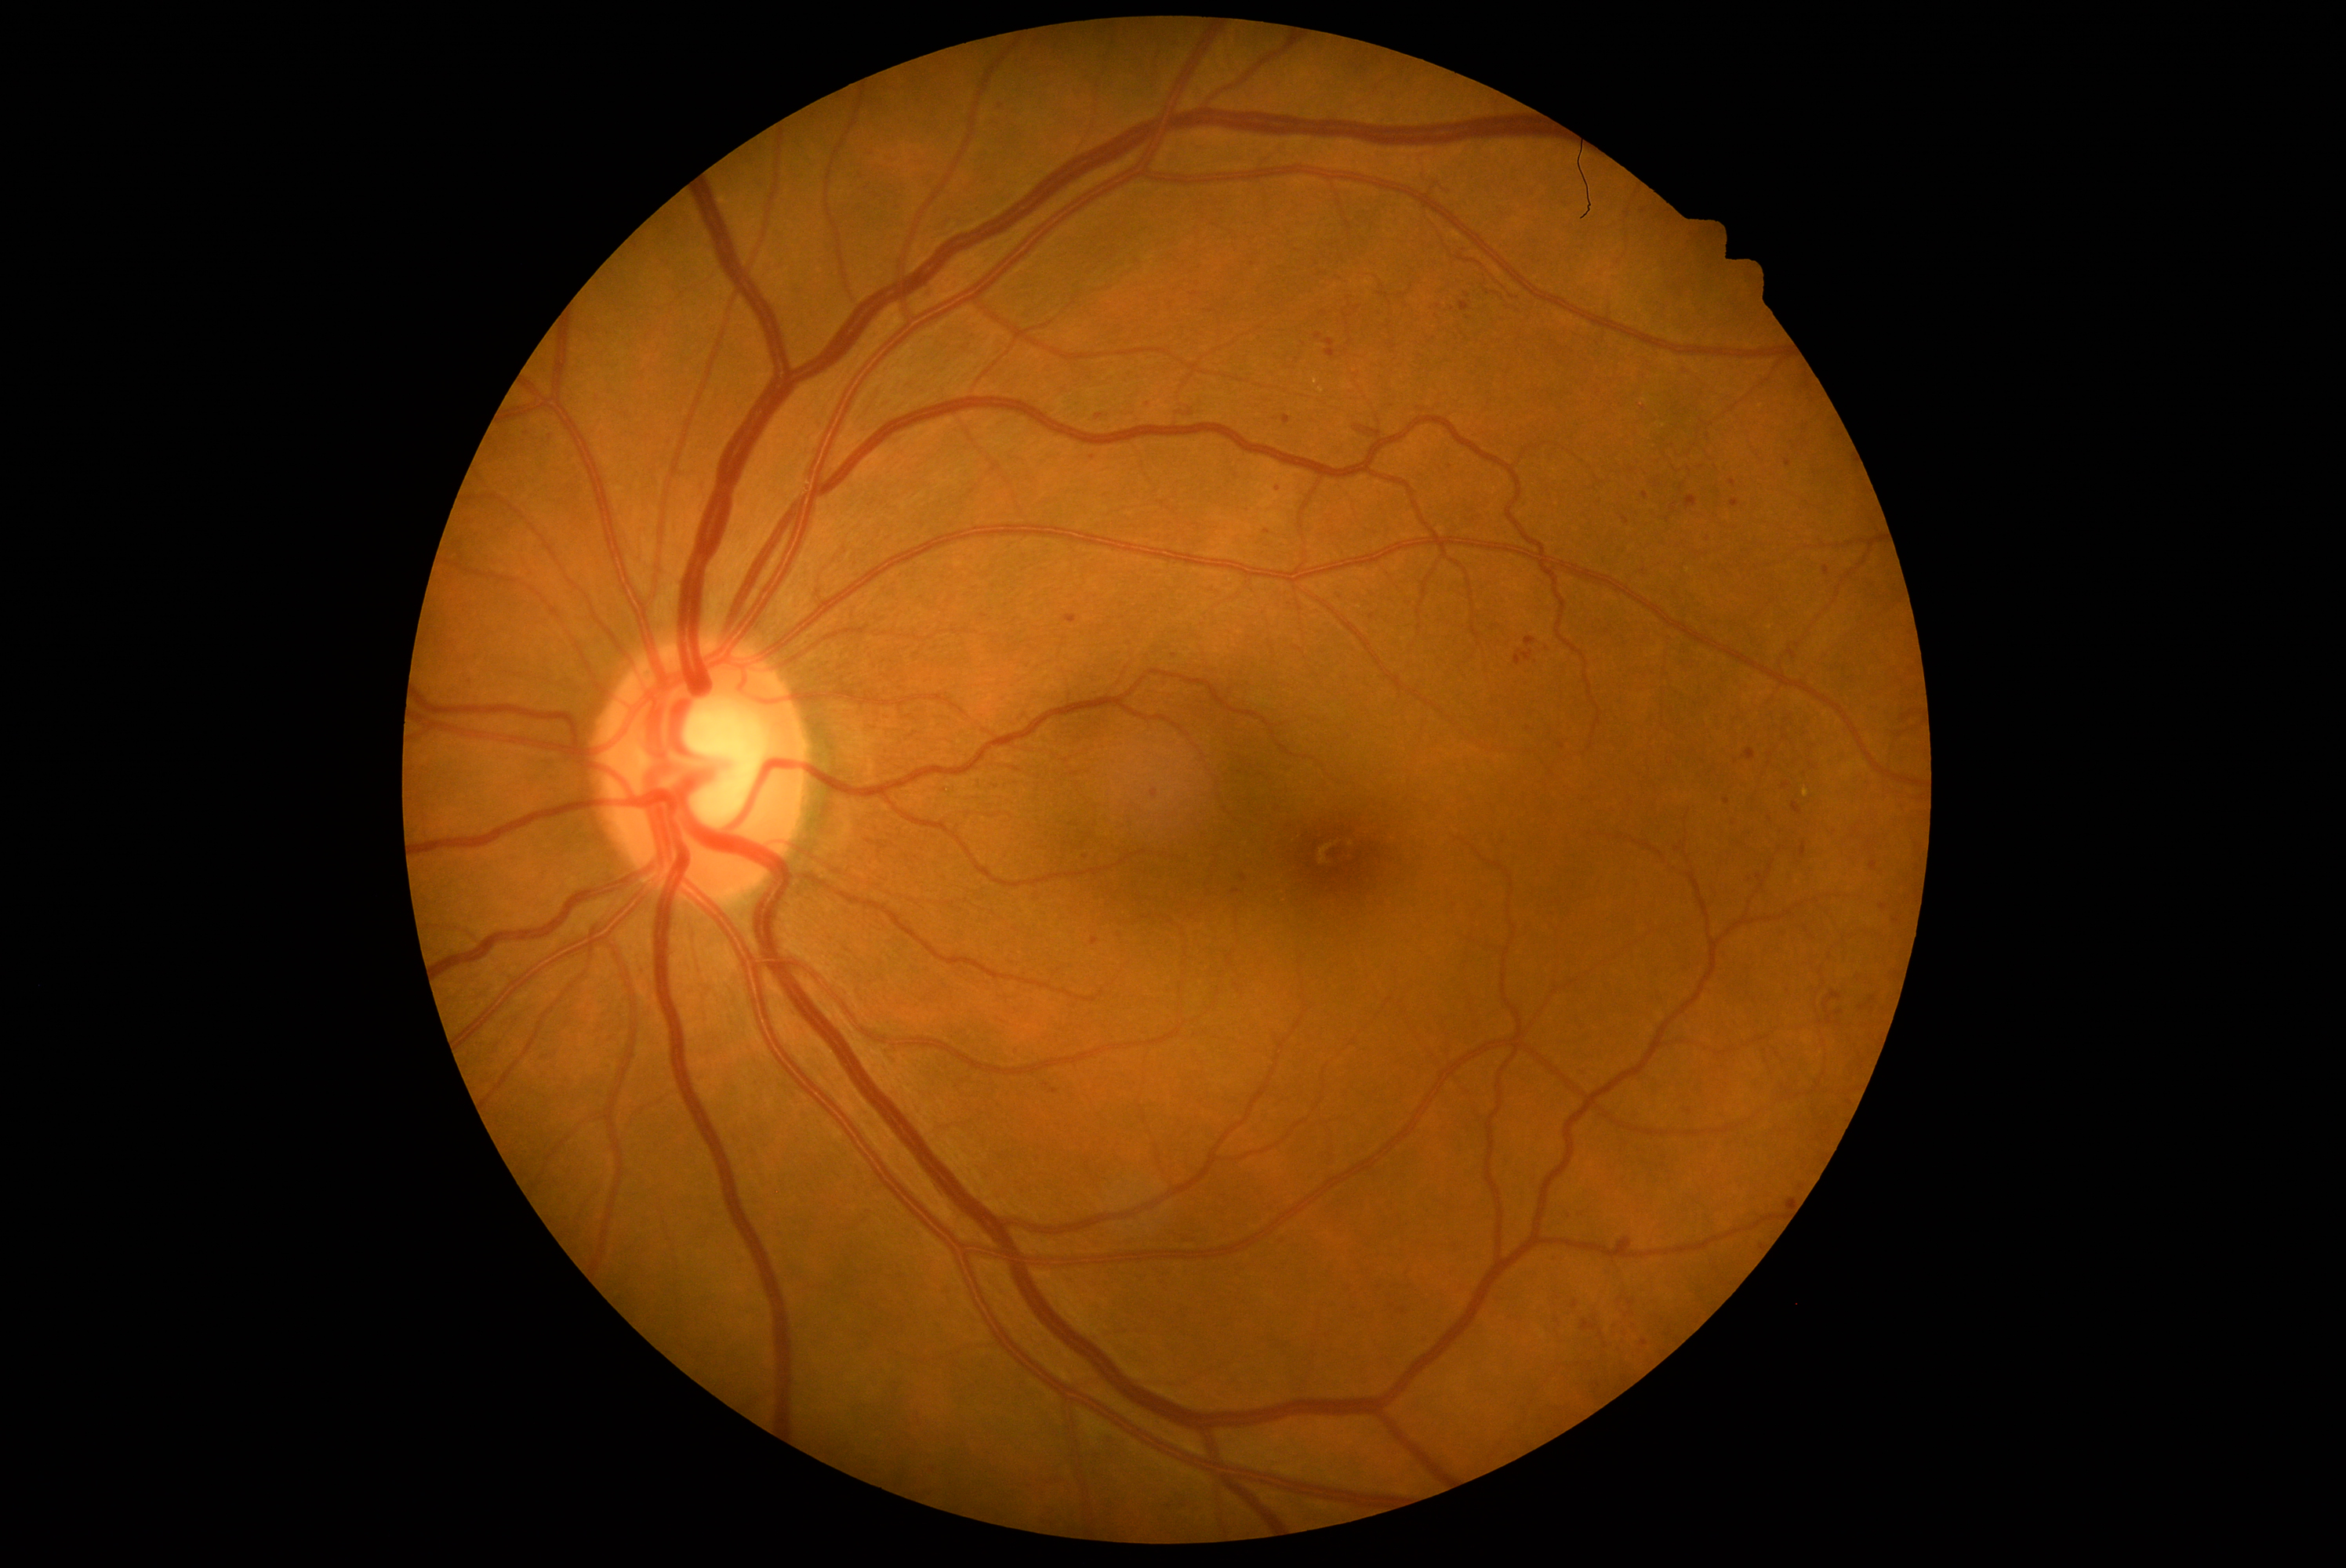

Diabetic retinopathy: 2/4
Selected lesions:
microaneurysms (more not shown) = <region>1870, 862, 1878, 871</region>; <region>921, 286, 935, 302</region>; <region>1613, 1348, 1624, 1356</region>; <region>1547, 1254, 1560, 1263</region>; <region>1099, 1434, 1122, 1450</region>; <region>1418, 1335, 1429, 1346</region>; <region>1629, 1324, 1640, 1334</region>; <region>1152, 789, 1158, 799</region>; <region>1326, 339, 1335, 360</region>; <region>1494, 1293, 1506, 1304</region>; <region>1572, 1067, 1586, 1078</region>
Small microaneurysms approximately at [1210, 311]; [1358, 309]; [1788, 462]; [1547, 650]; [1863, 1009]; [1644, 211]; [1884, 909]; [1787, 719]